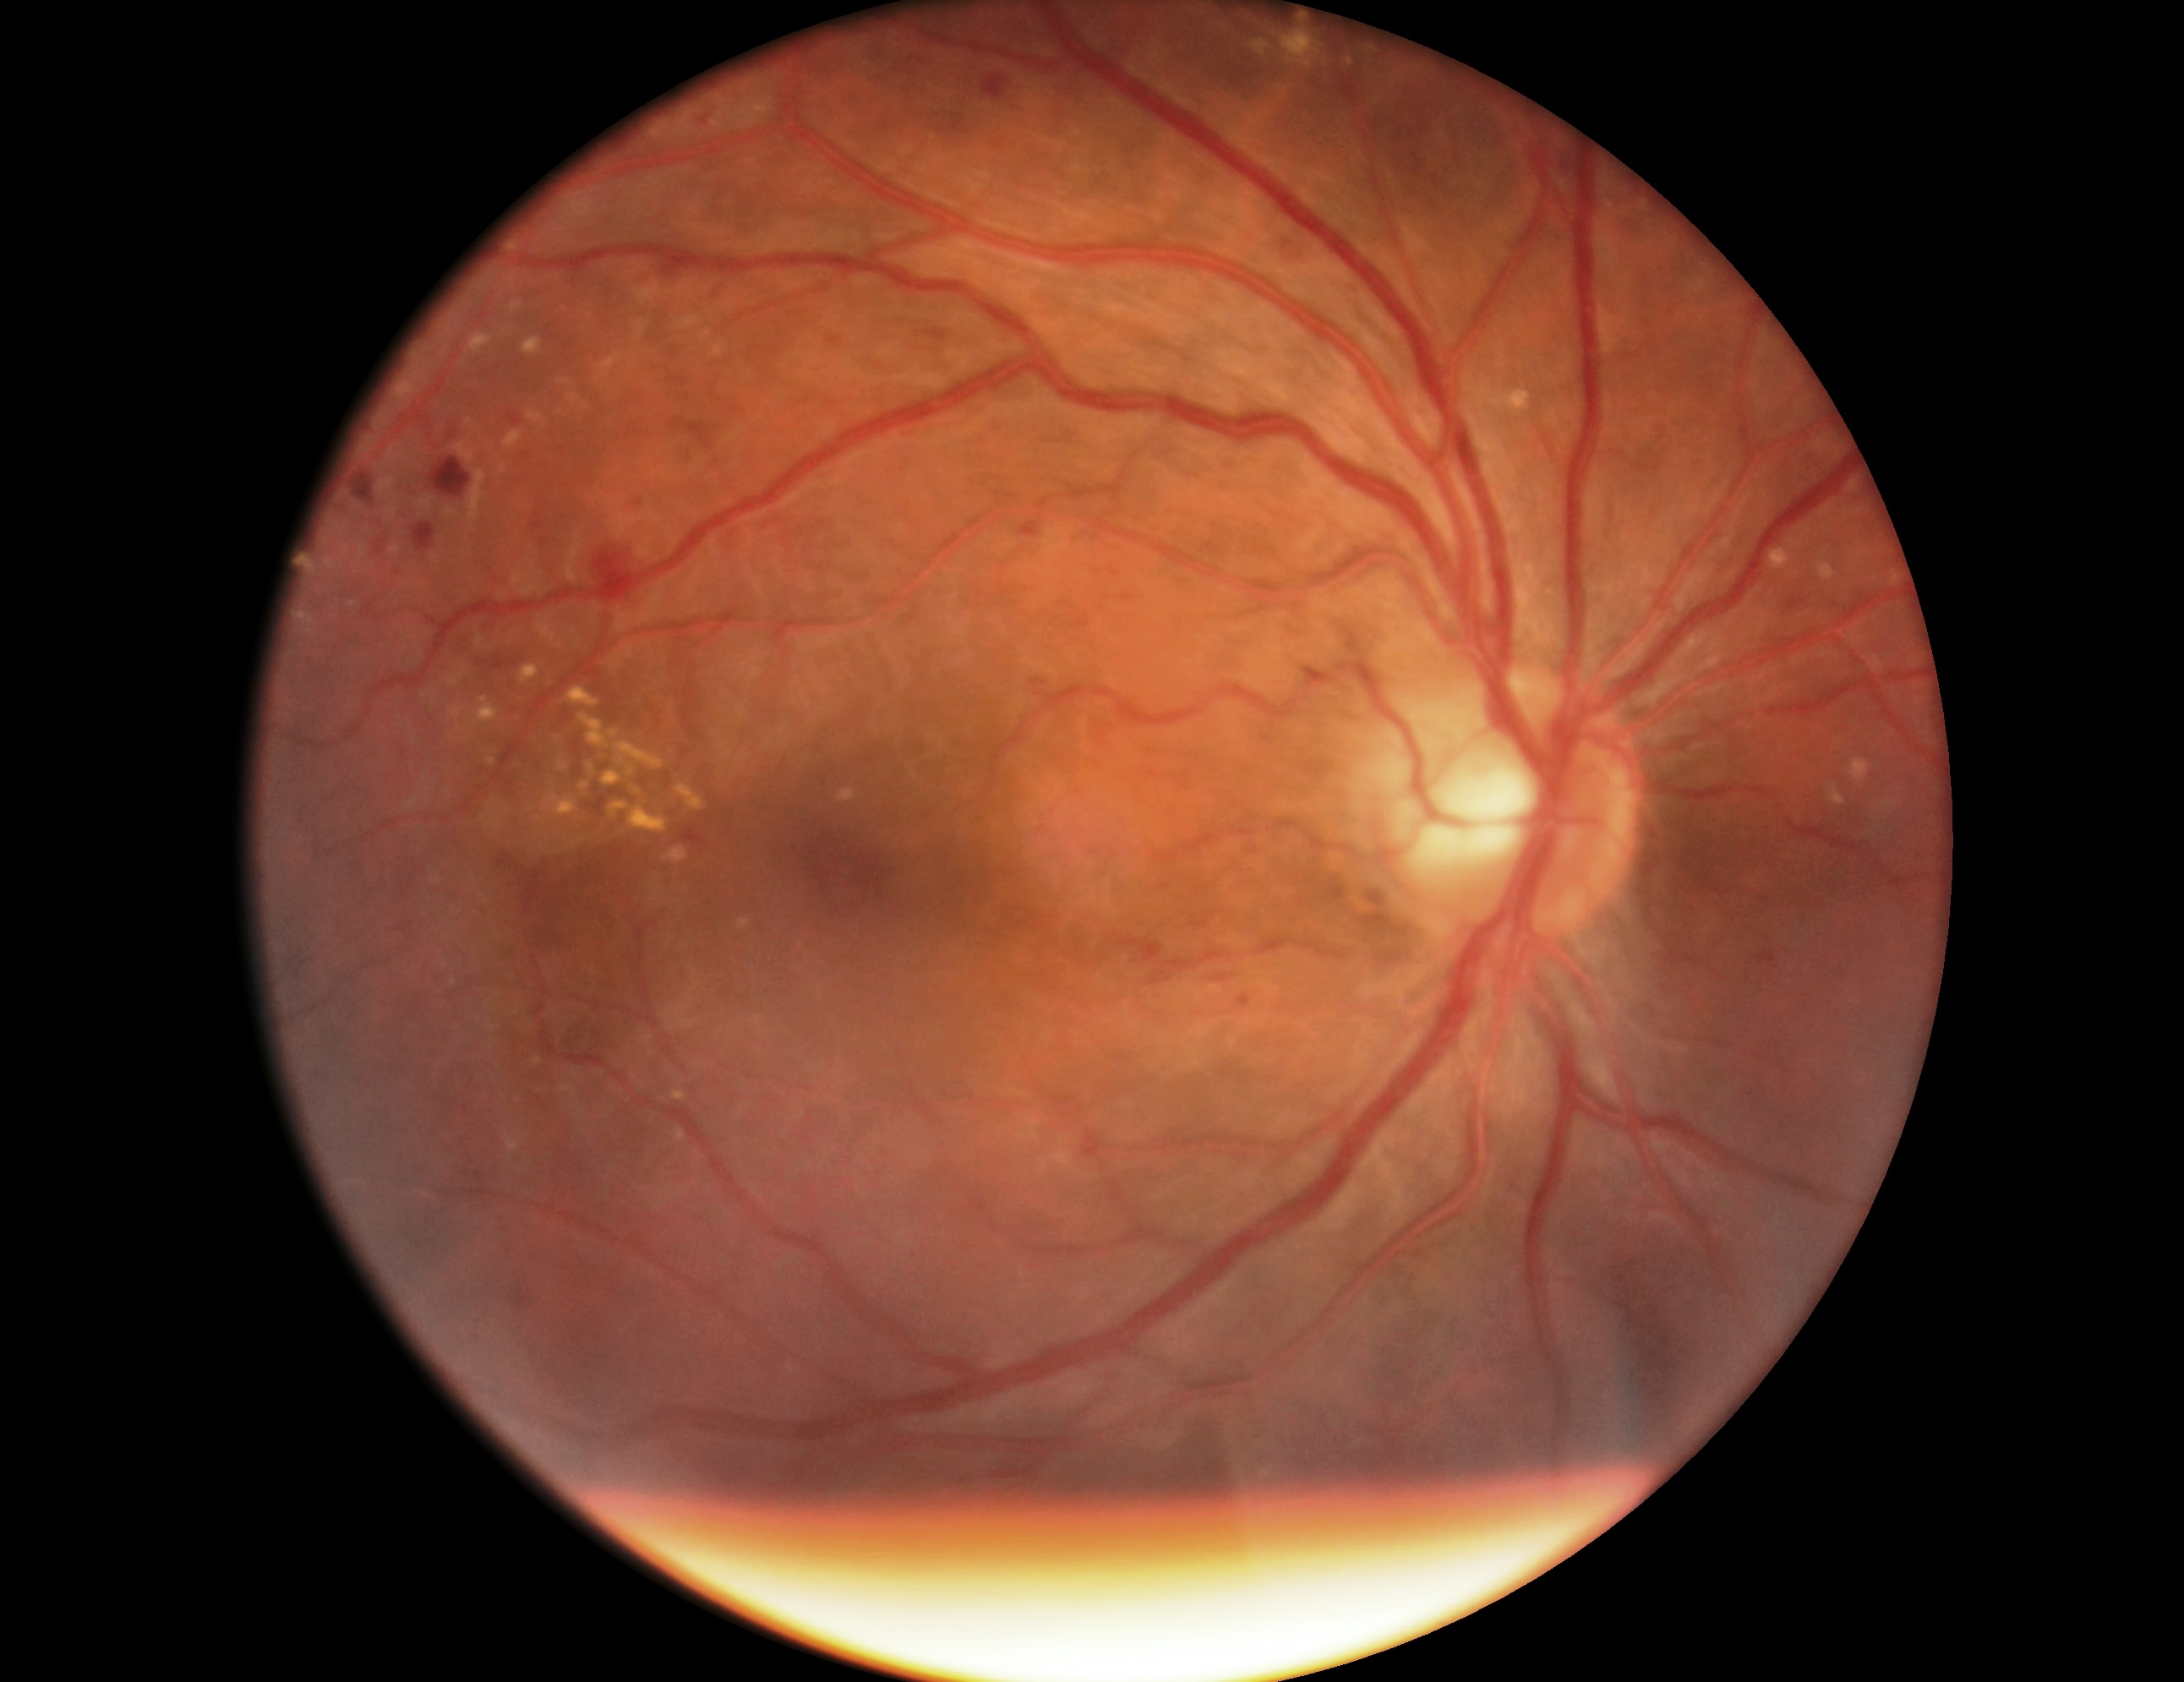
DR: 2/4.